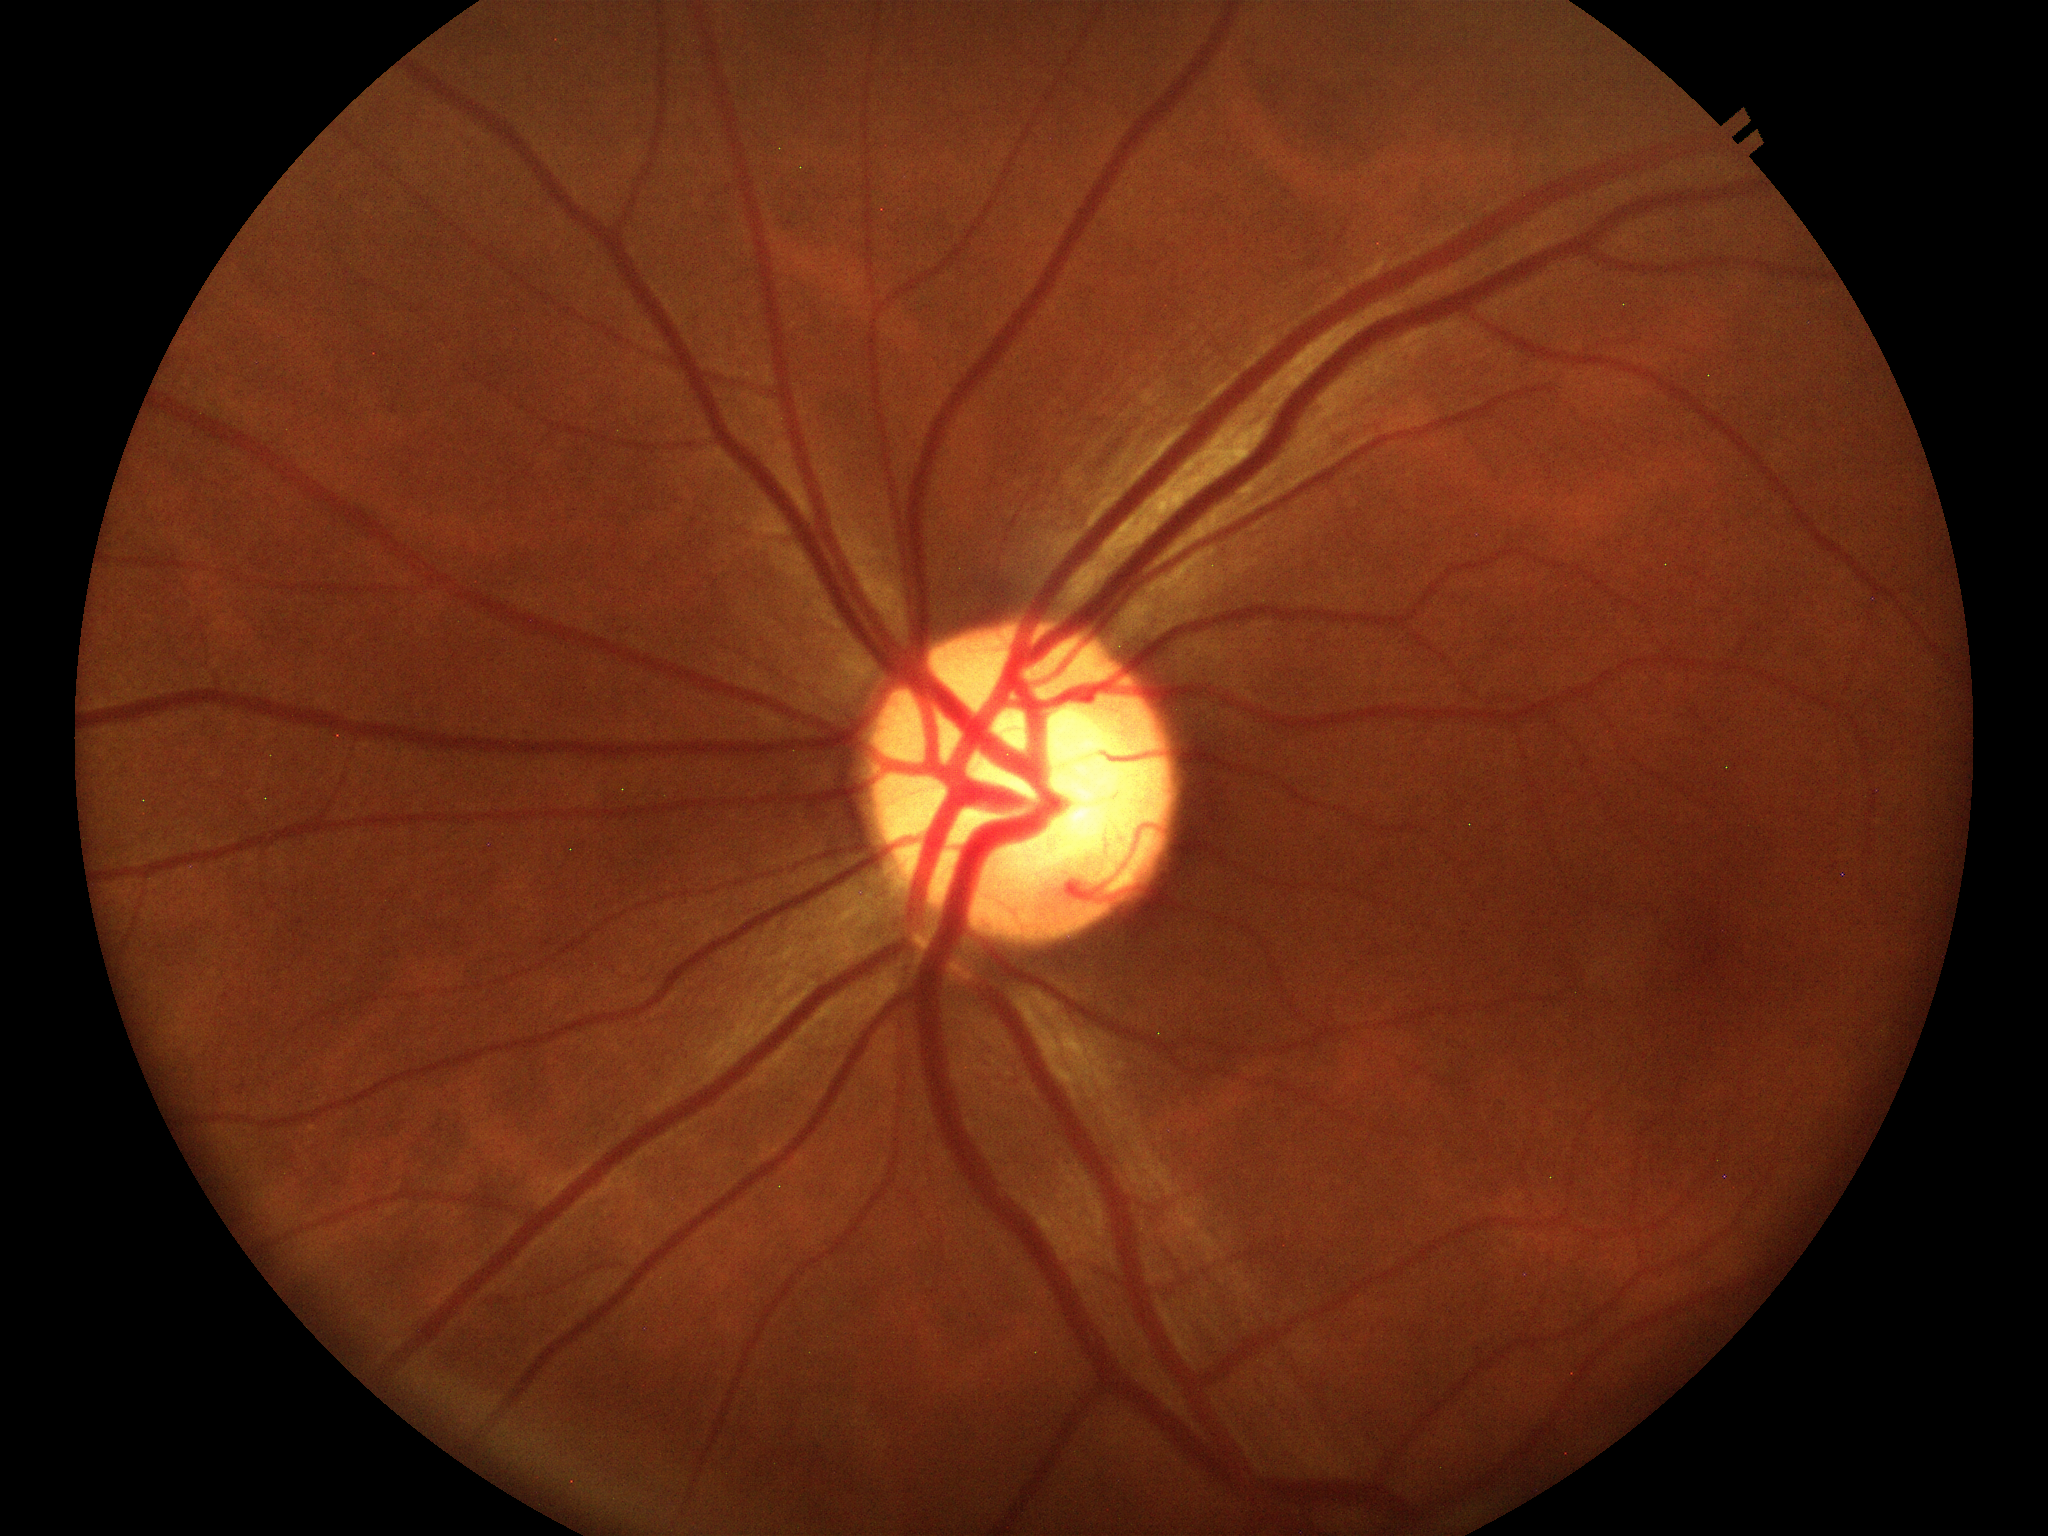
Glaucoma evaluation: not suspect. VCDR is 0.57.